Retinal fundus photograph. 2352x1568px.
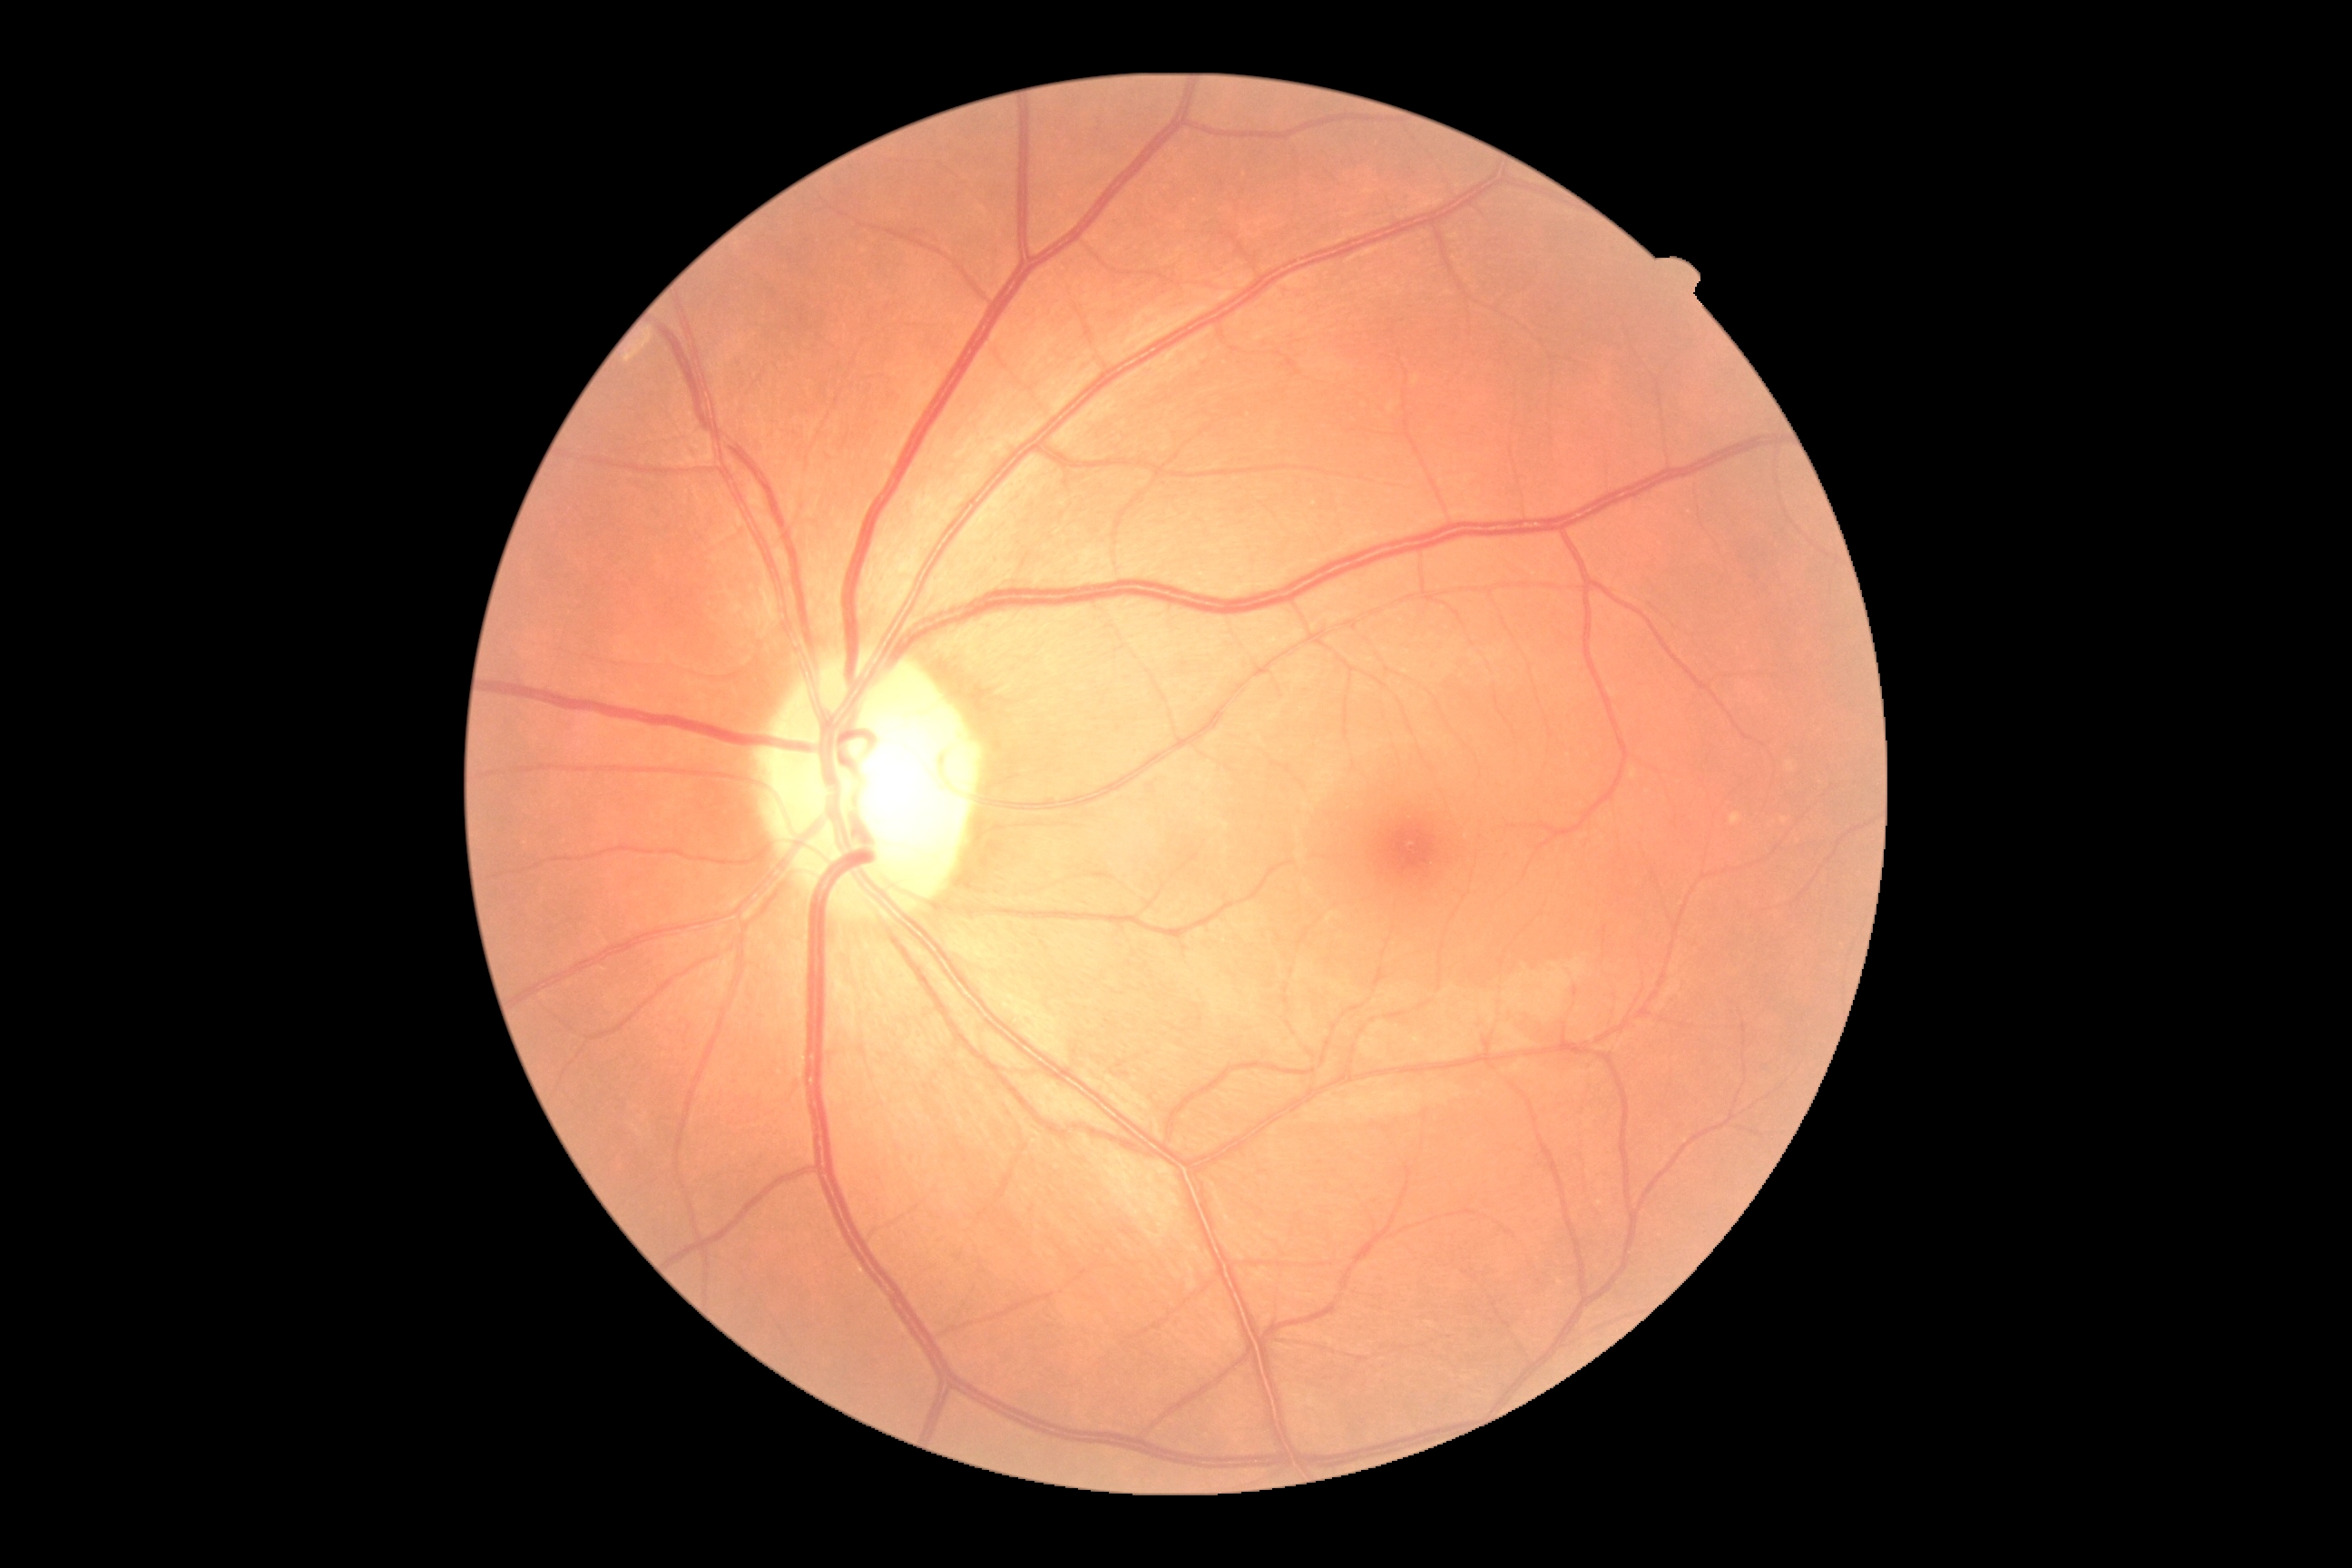
DR stage: grade 0 (no apparent retinopathy).